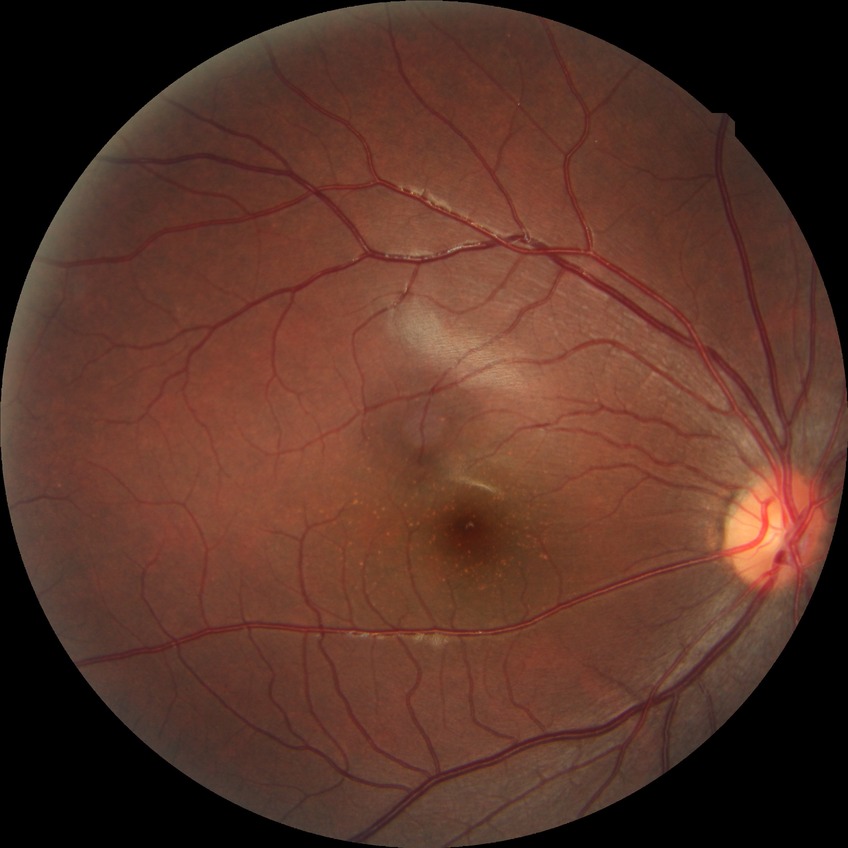 Diabetic retinopathy (DR): no diabetic retinopathy (NDR).